Retinal fundus photograph: 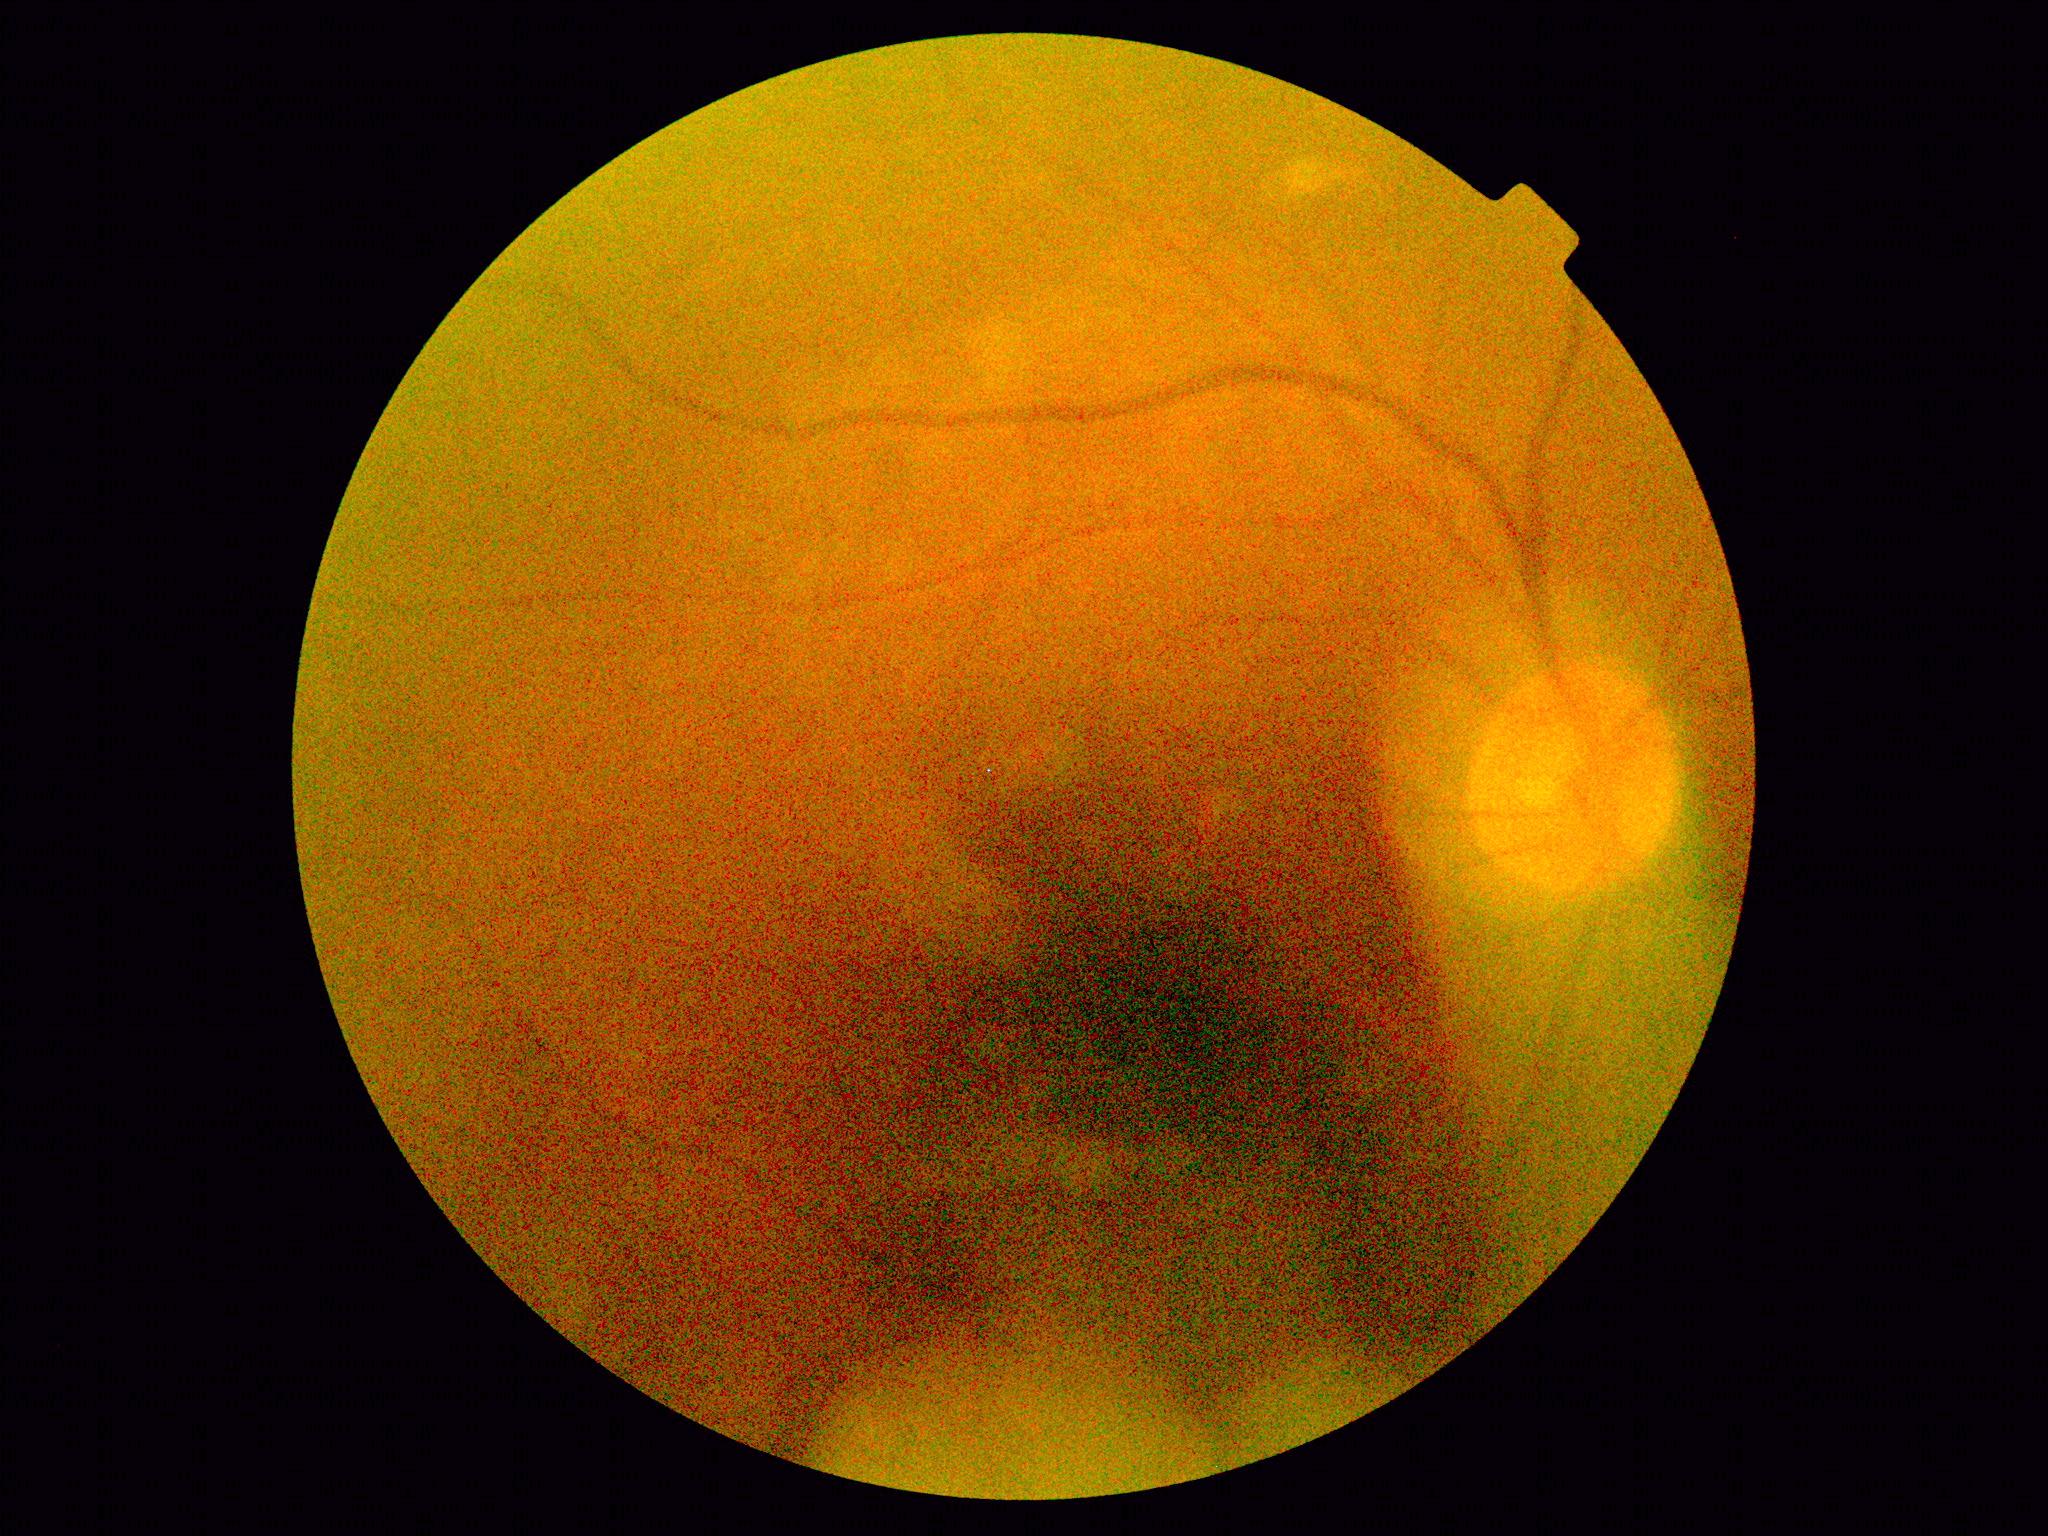 Findings:
• diabetic retinopathy (DR) — ungradable